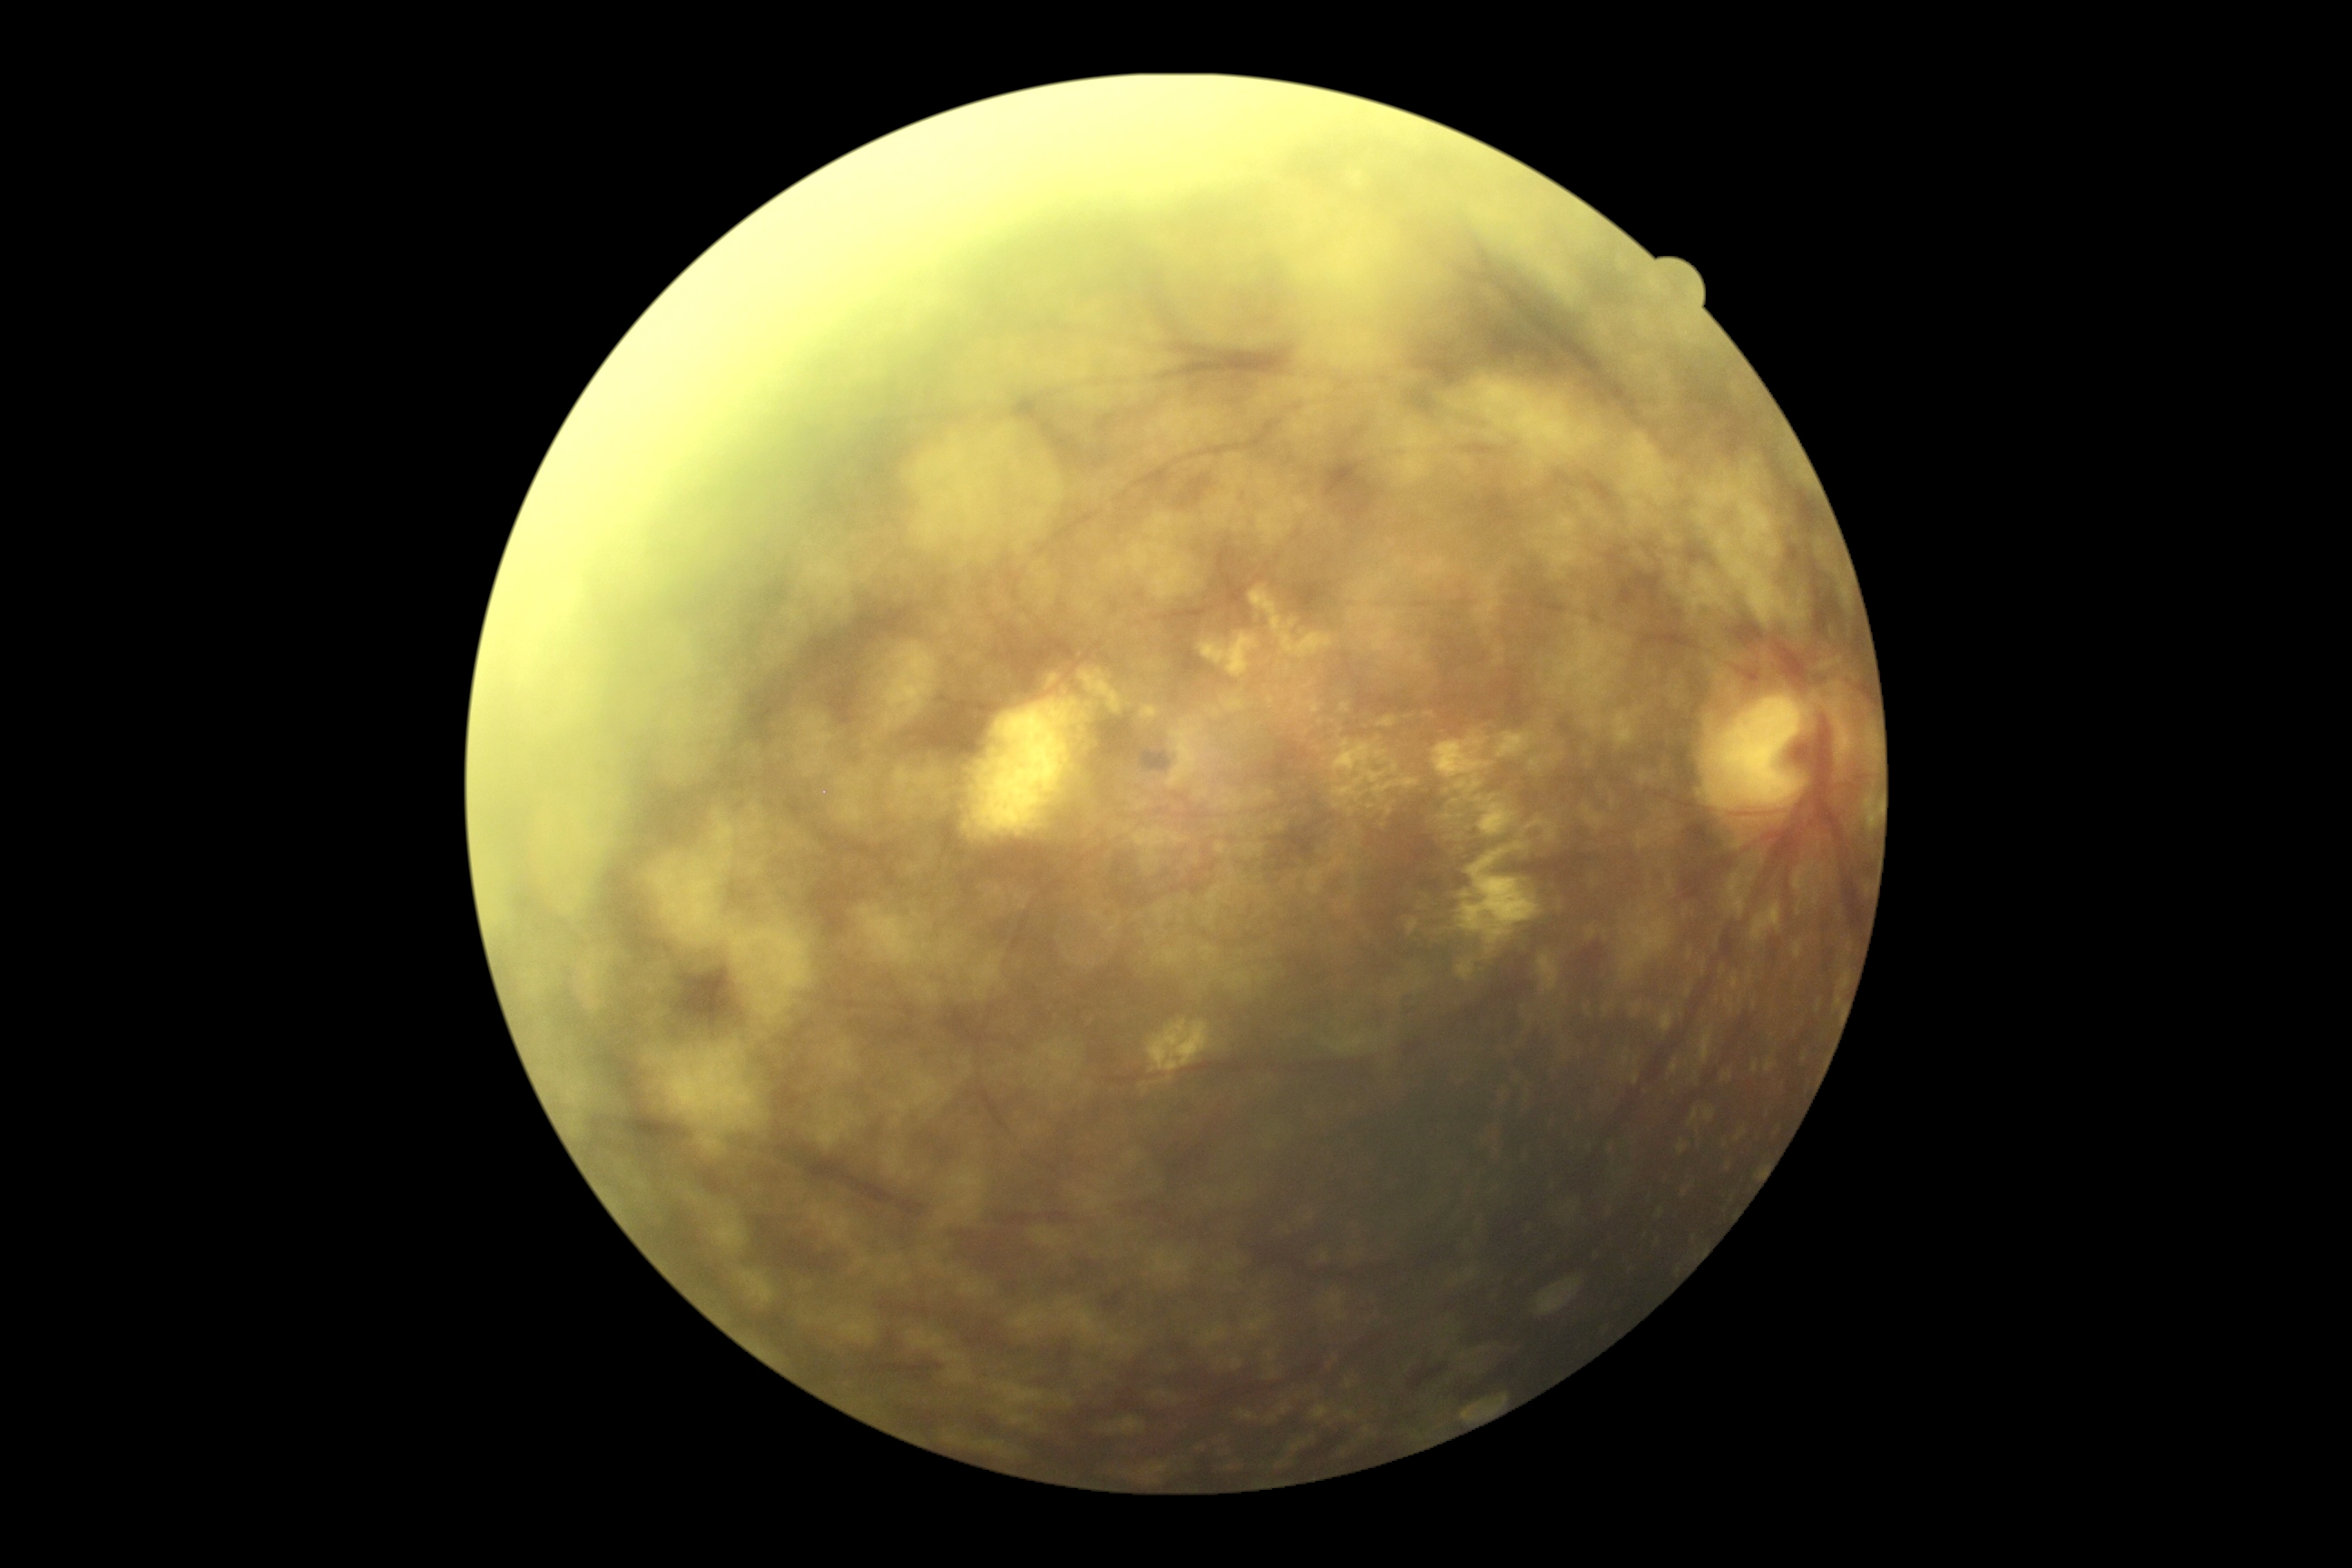
DR class: non-proliferative diabetic retinopathy. DR severity is moderate NPDR (grade 2).